848x848px. Camera: NIDEK AFC-230. Graded on the modified Davis scale — 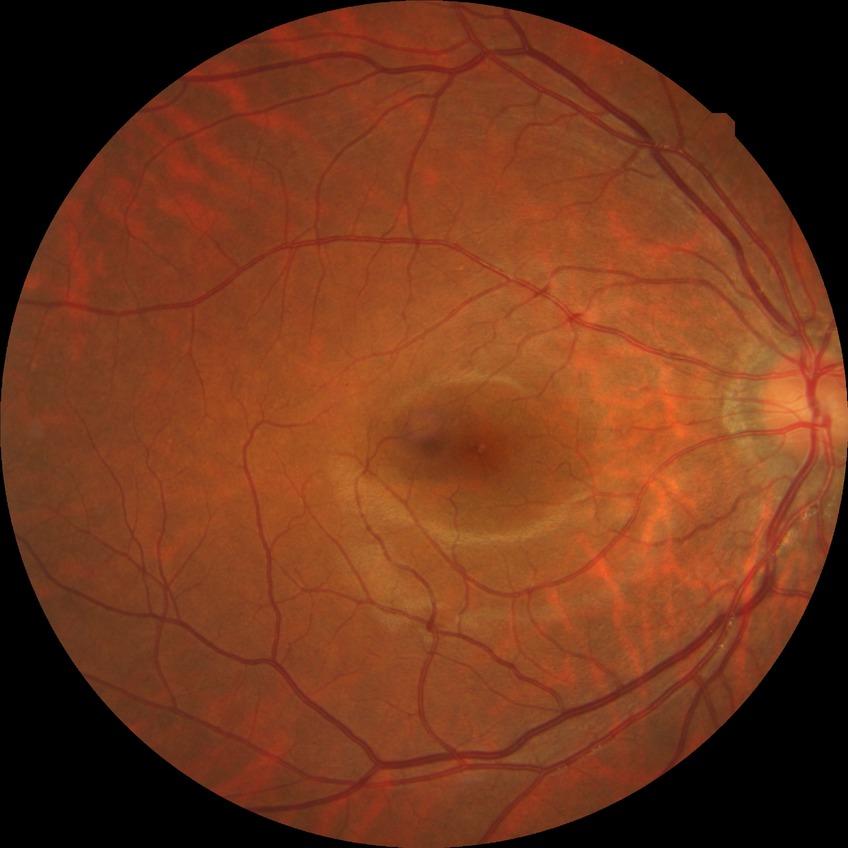

DR grade is NDR.